45-degree field of view, 2352 x 1568 pixels, color fundus image
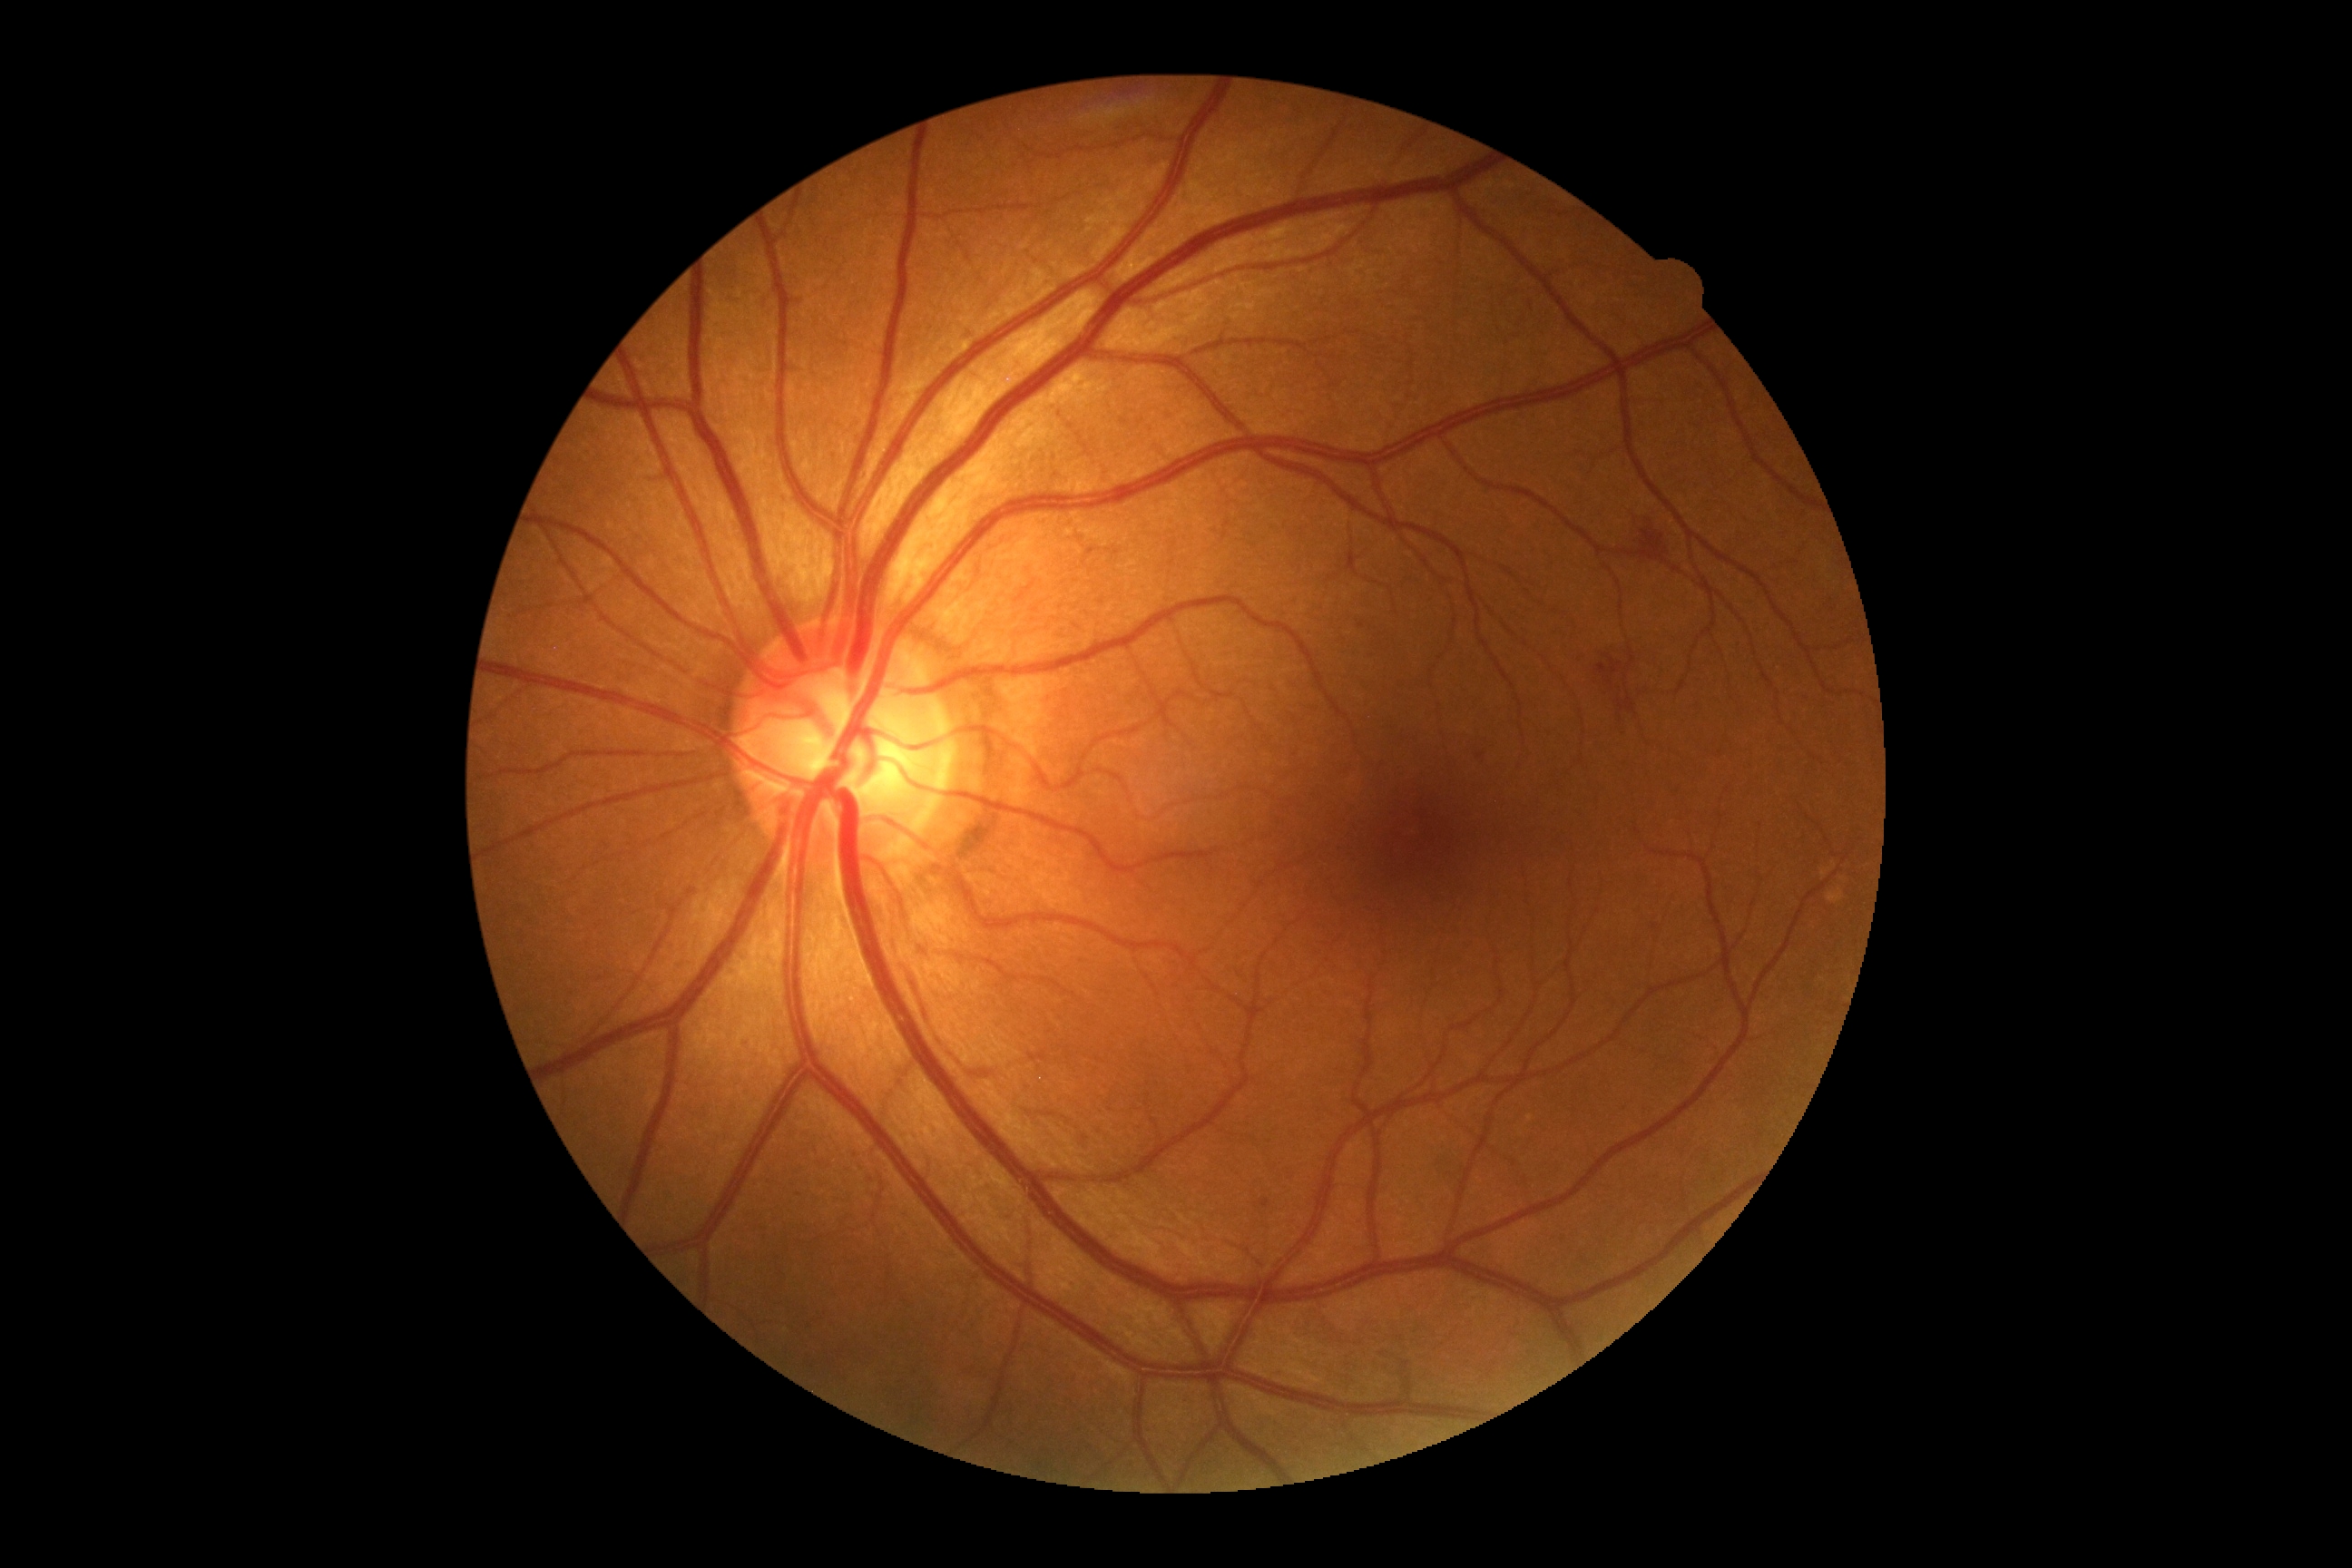

dr_category: non-proliferative diabetic retinopathy
dr_grade: moderate NPDR (grade 2)